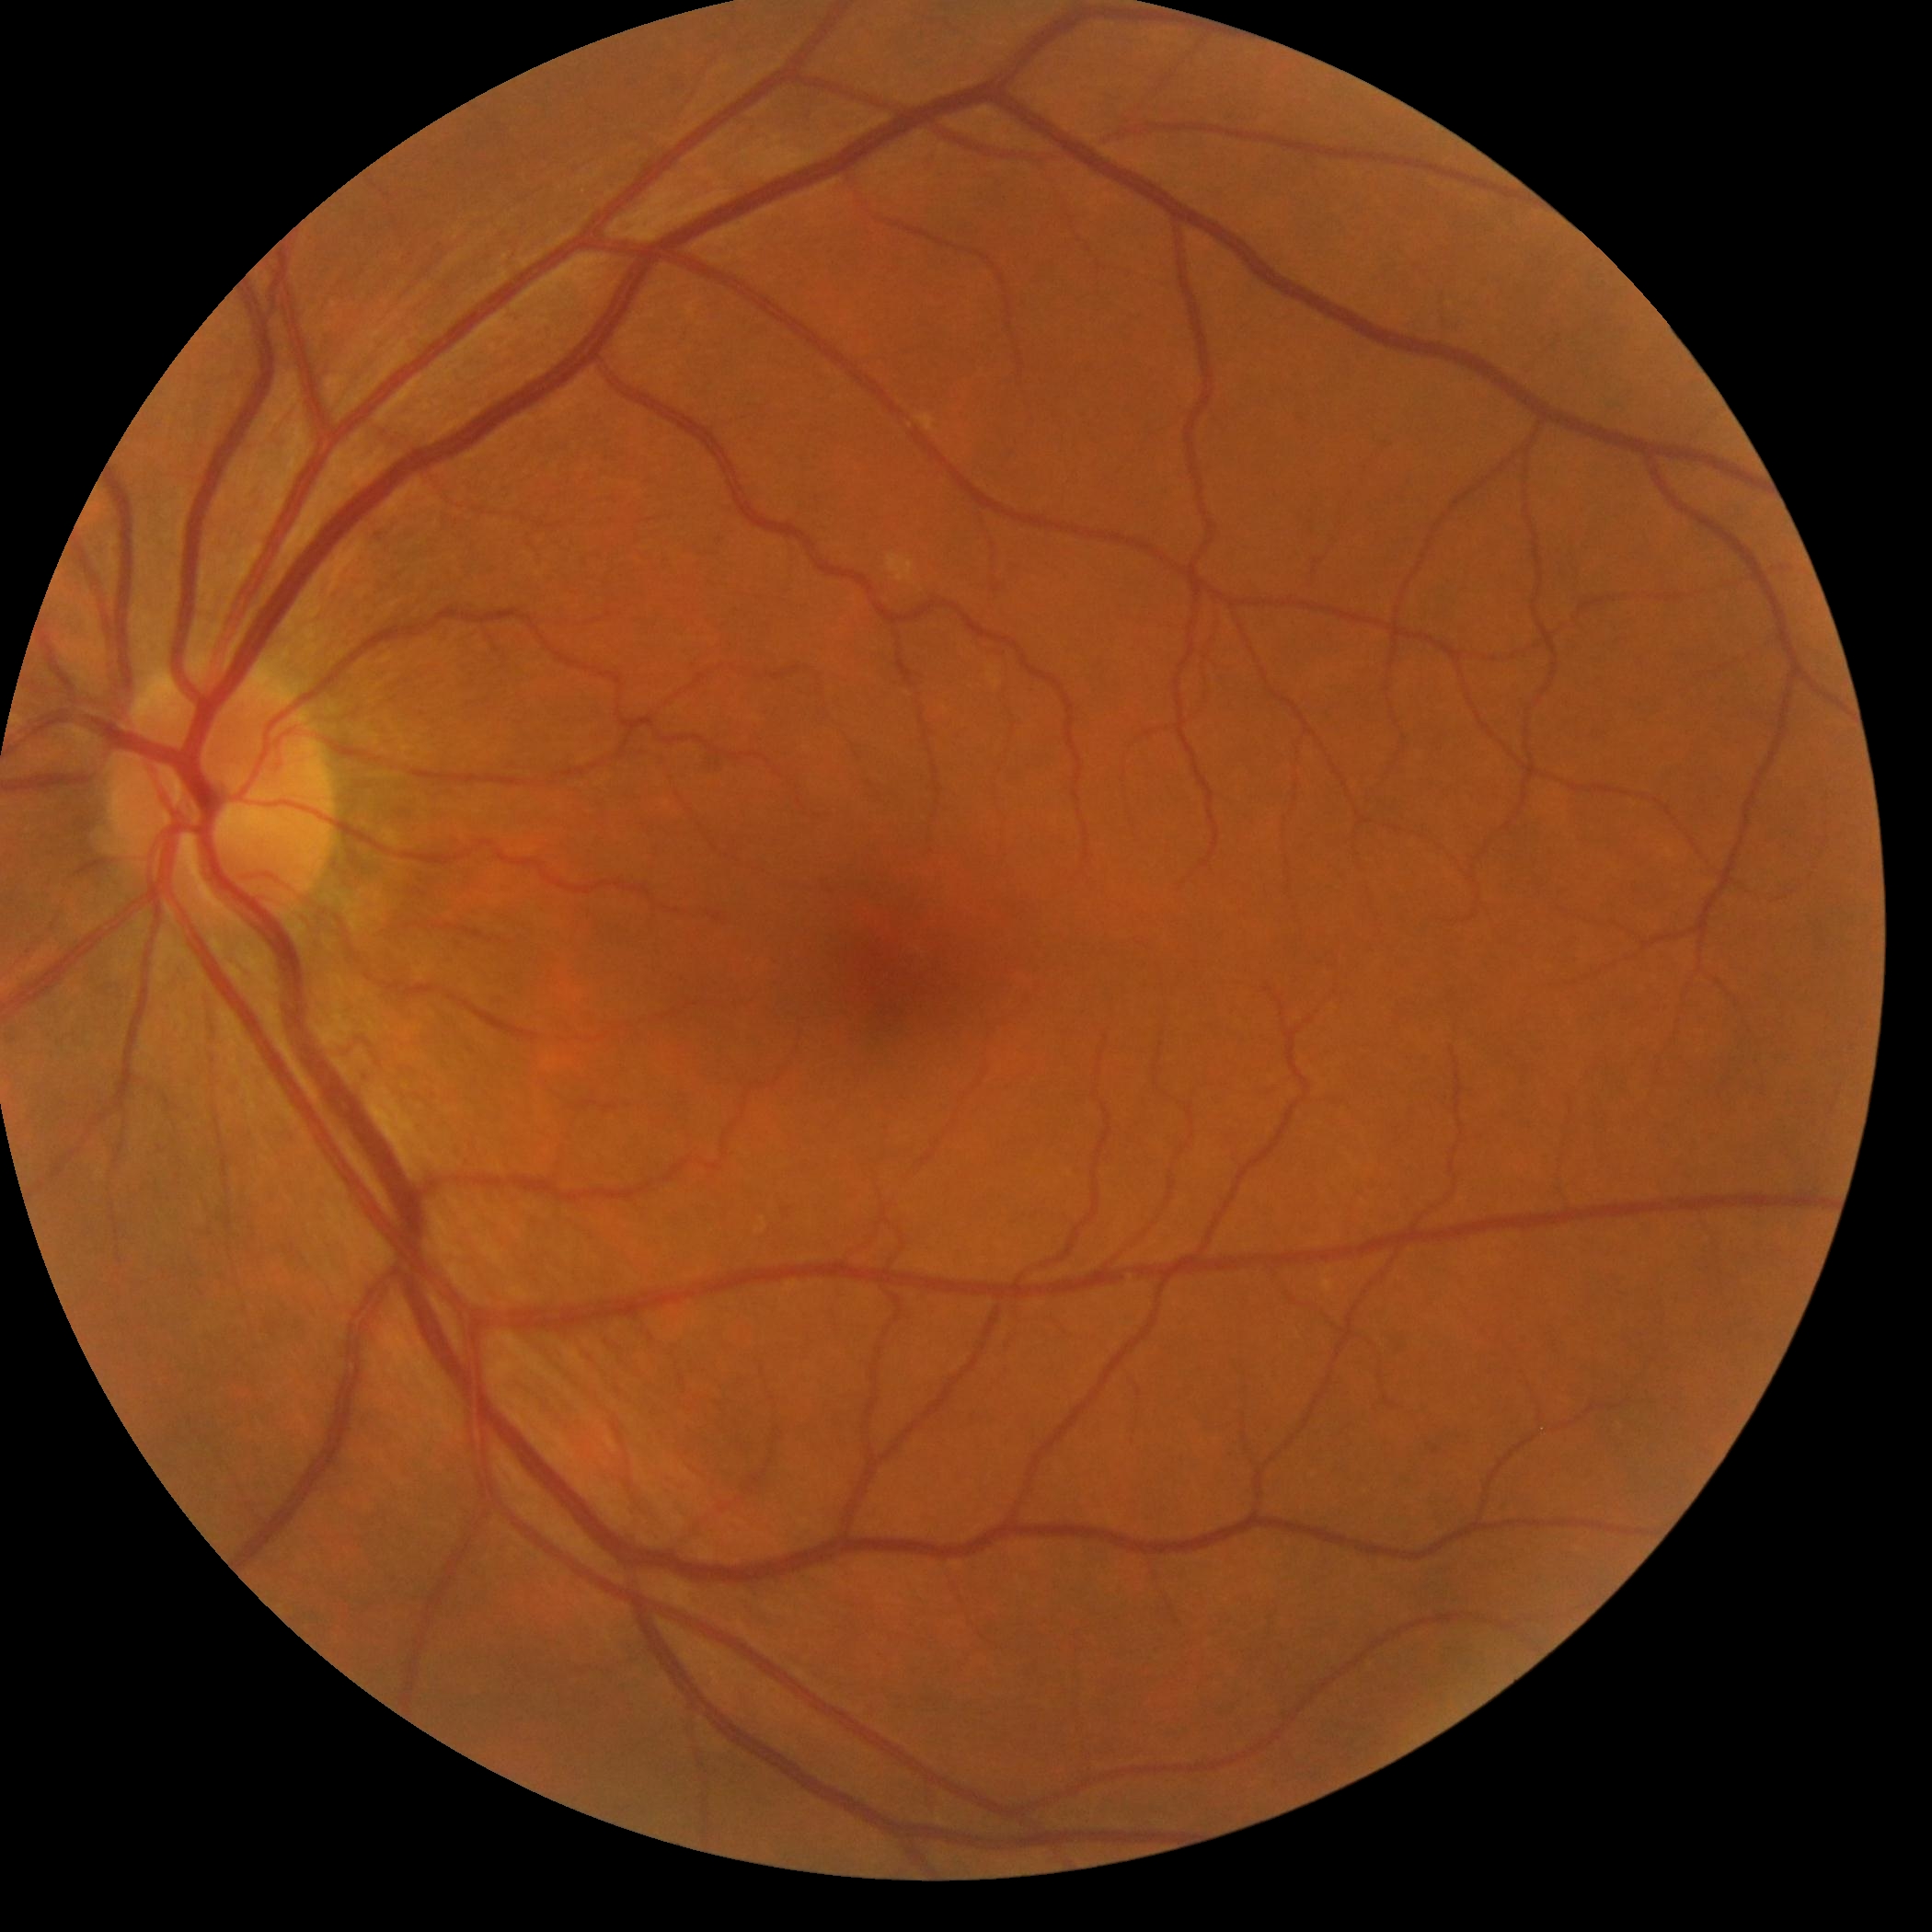 Findings:
- DR impression: no DR findings
- diabetic retinopathy (DR): grade 0 — no visible signs of diabetic retinopathy